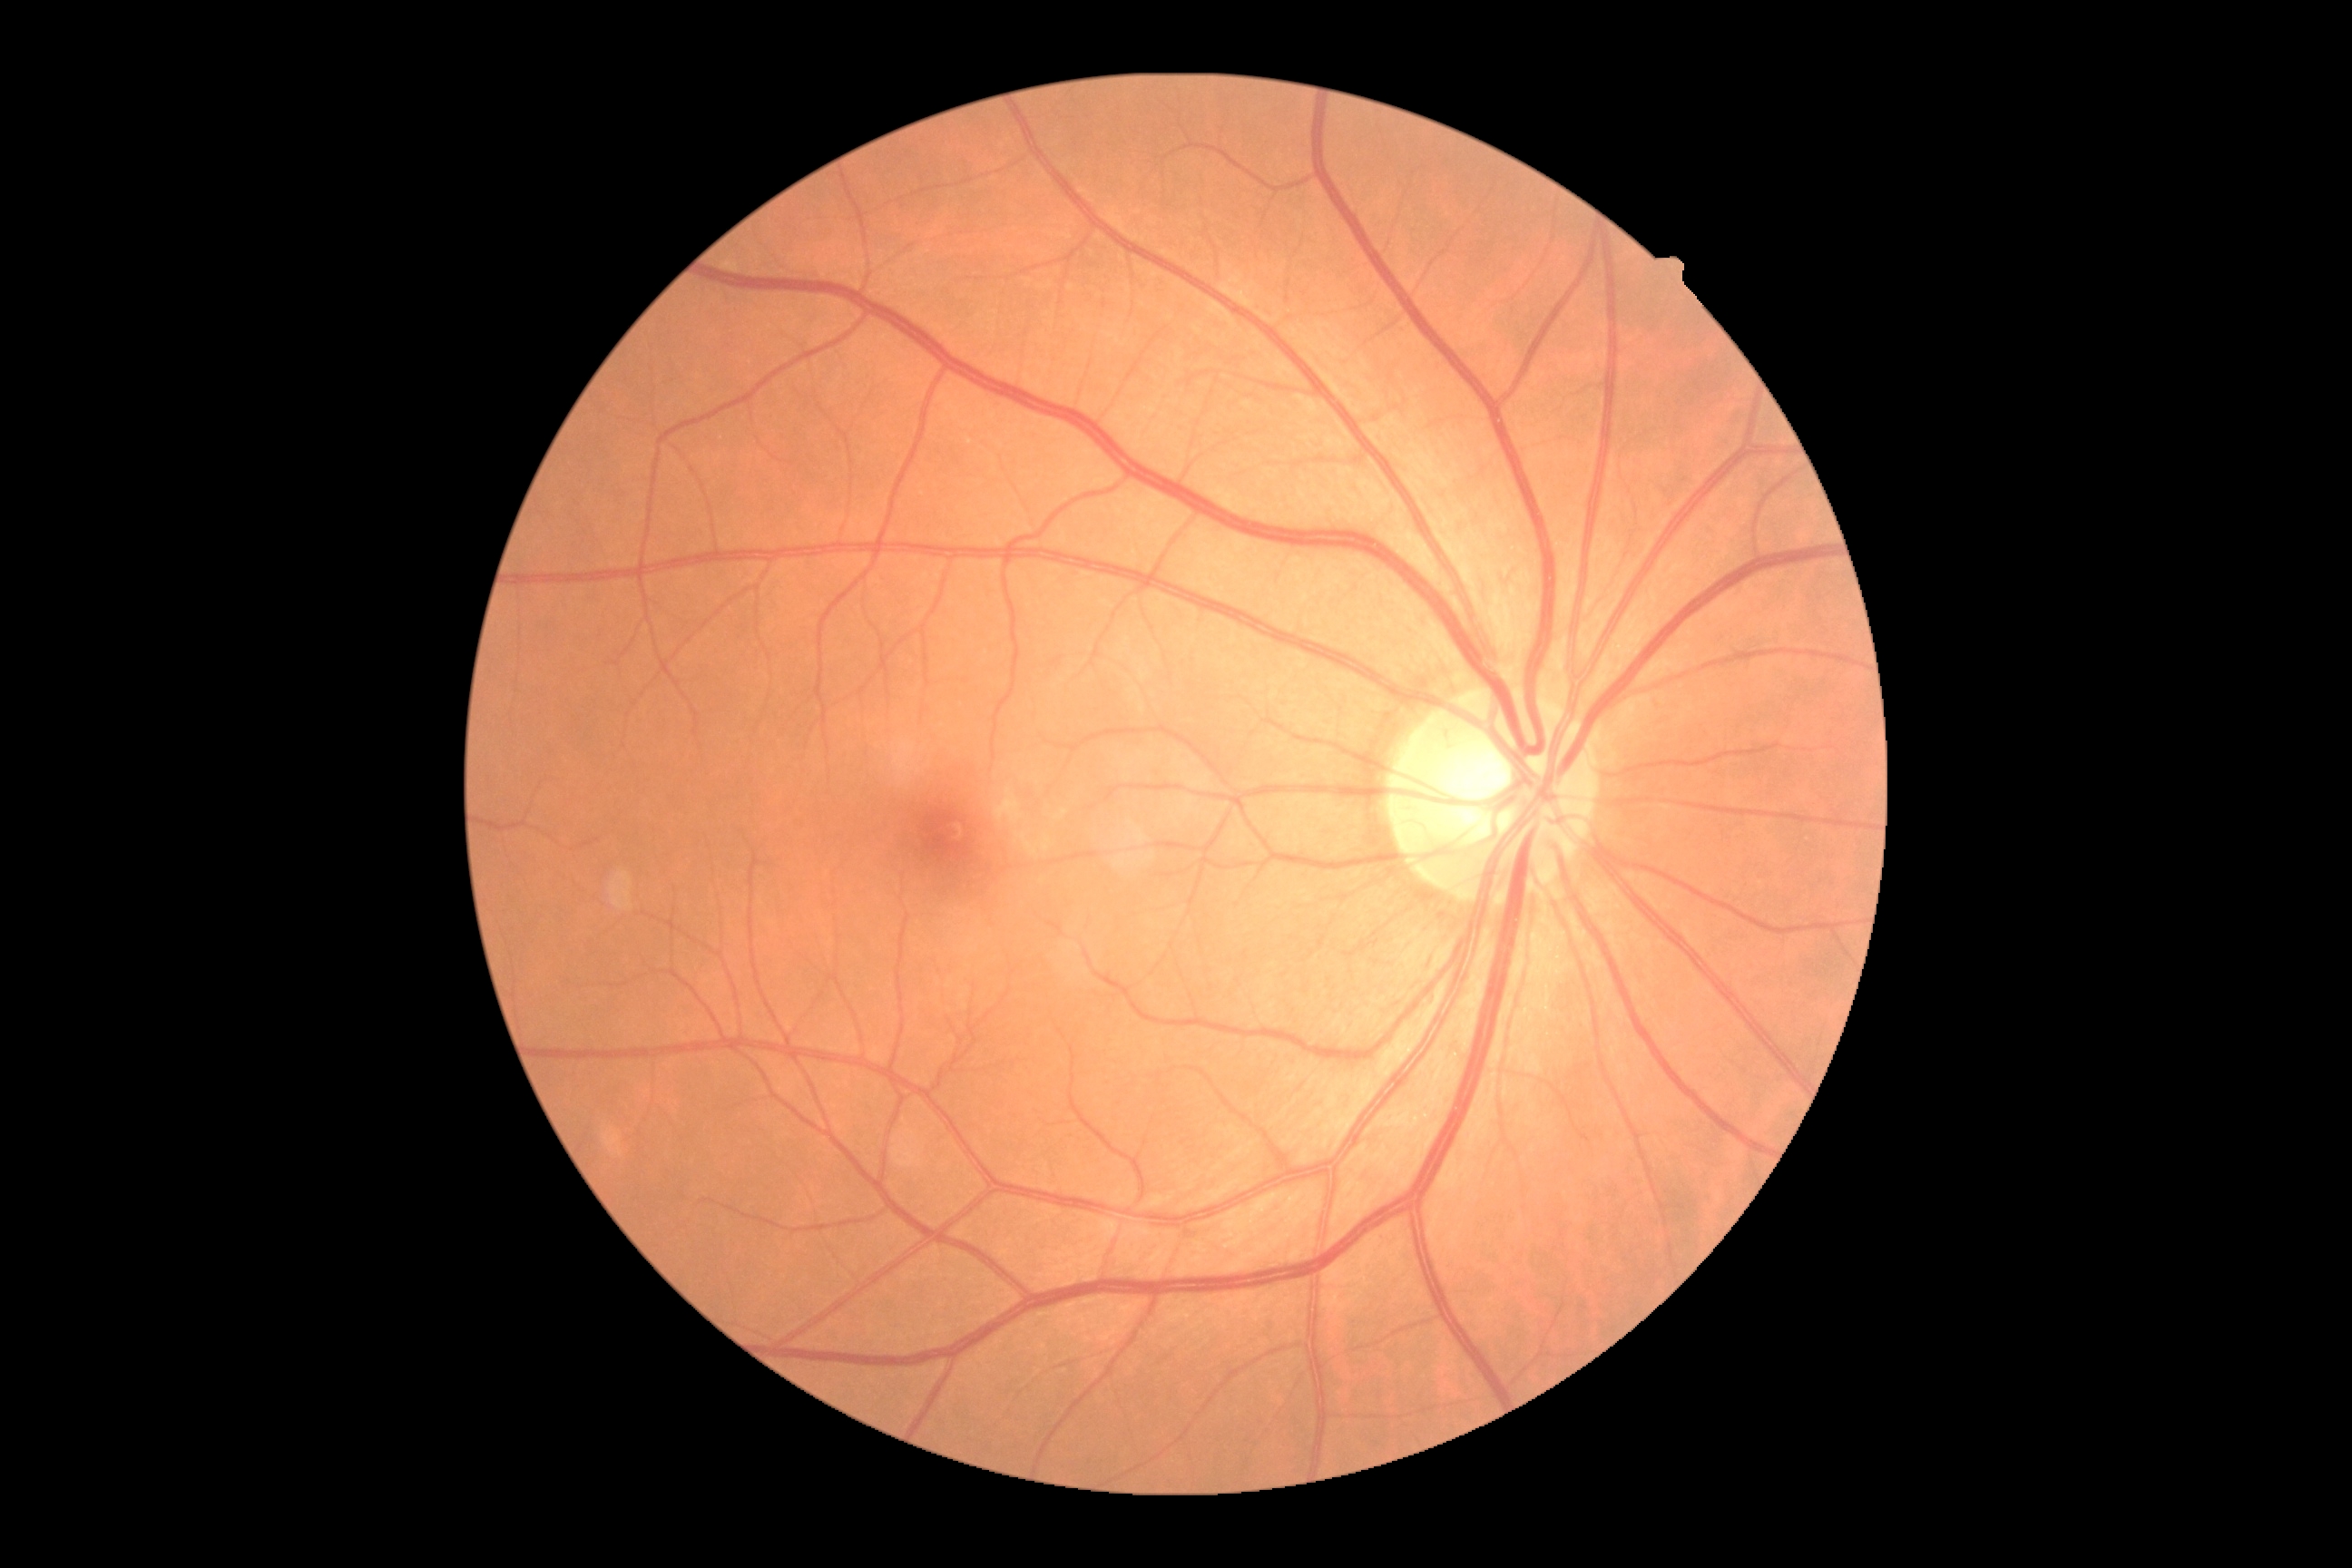

Diabetic retinopathy is 0 — no visible signs of diabetic retinopathy.